640x480px · pediatric wide-field fundus photograph — 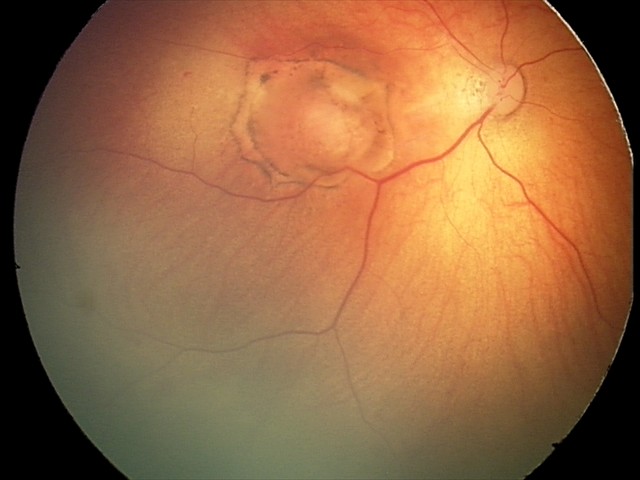
From an examination with diagnosis of toxoplasmosis chorioretinitis.